Phoenix ICON wide-field infant fundus image; acquired on the Phoenix ICON.
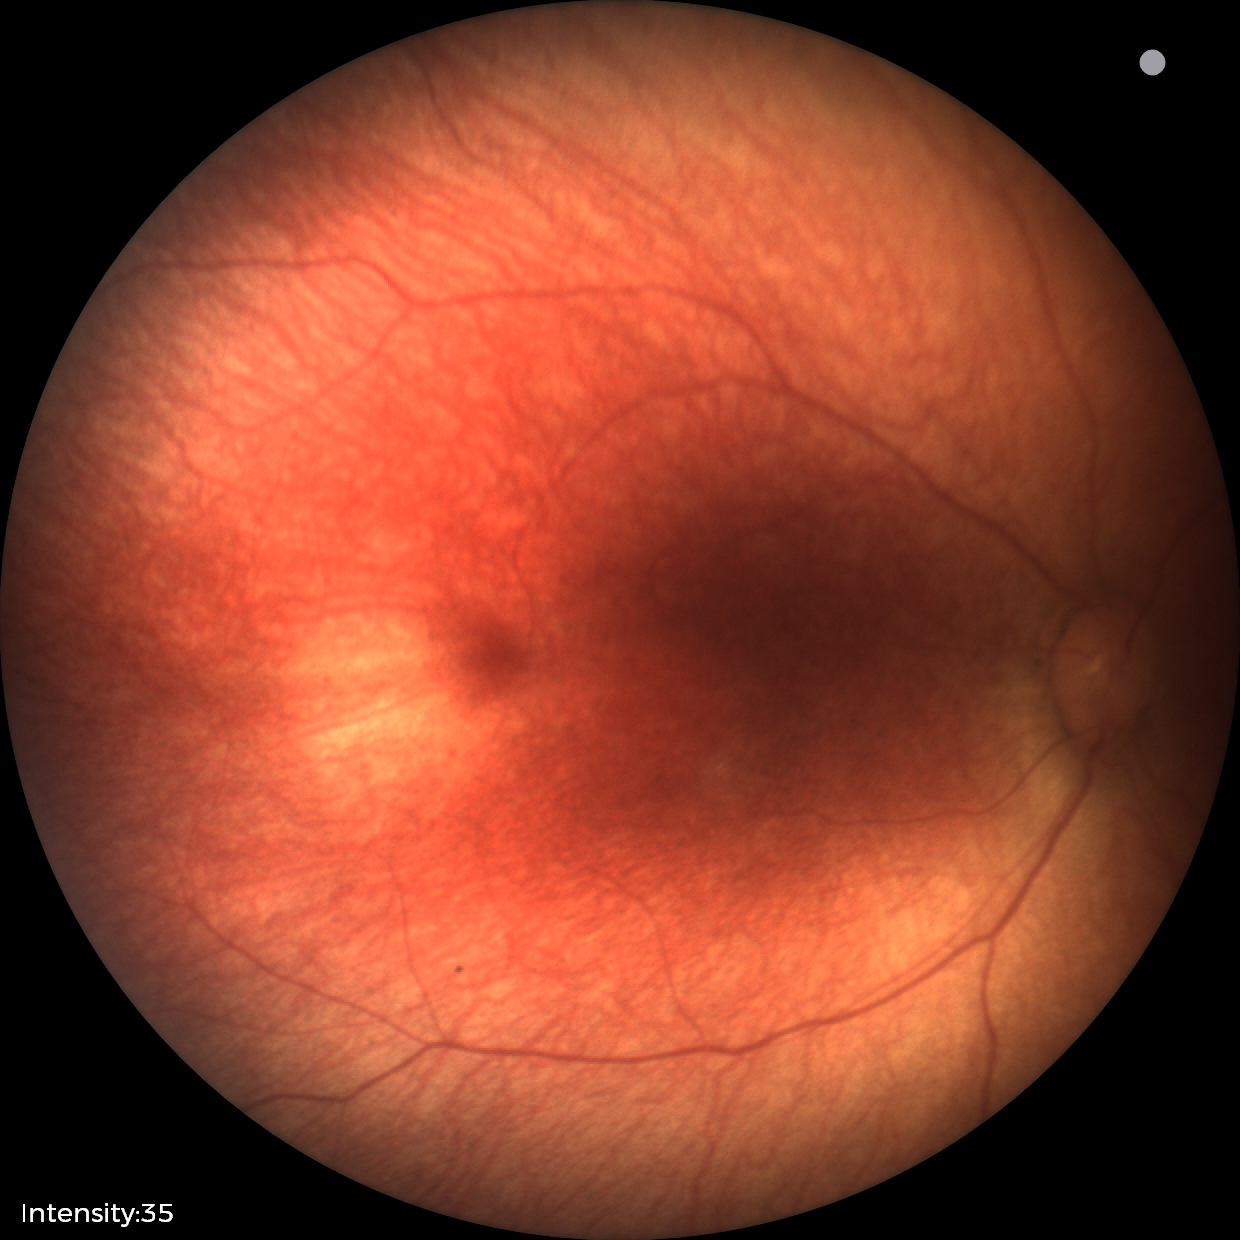
Screening examination diagnosed as physiological.